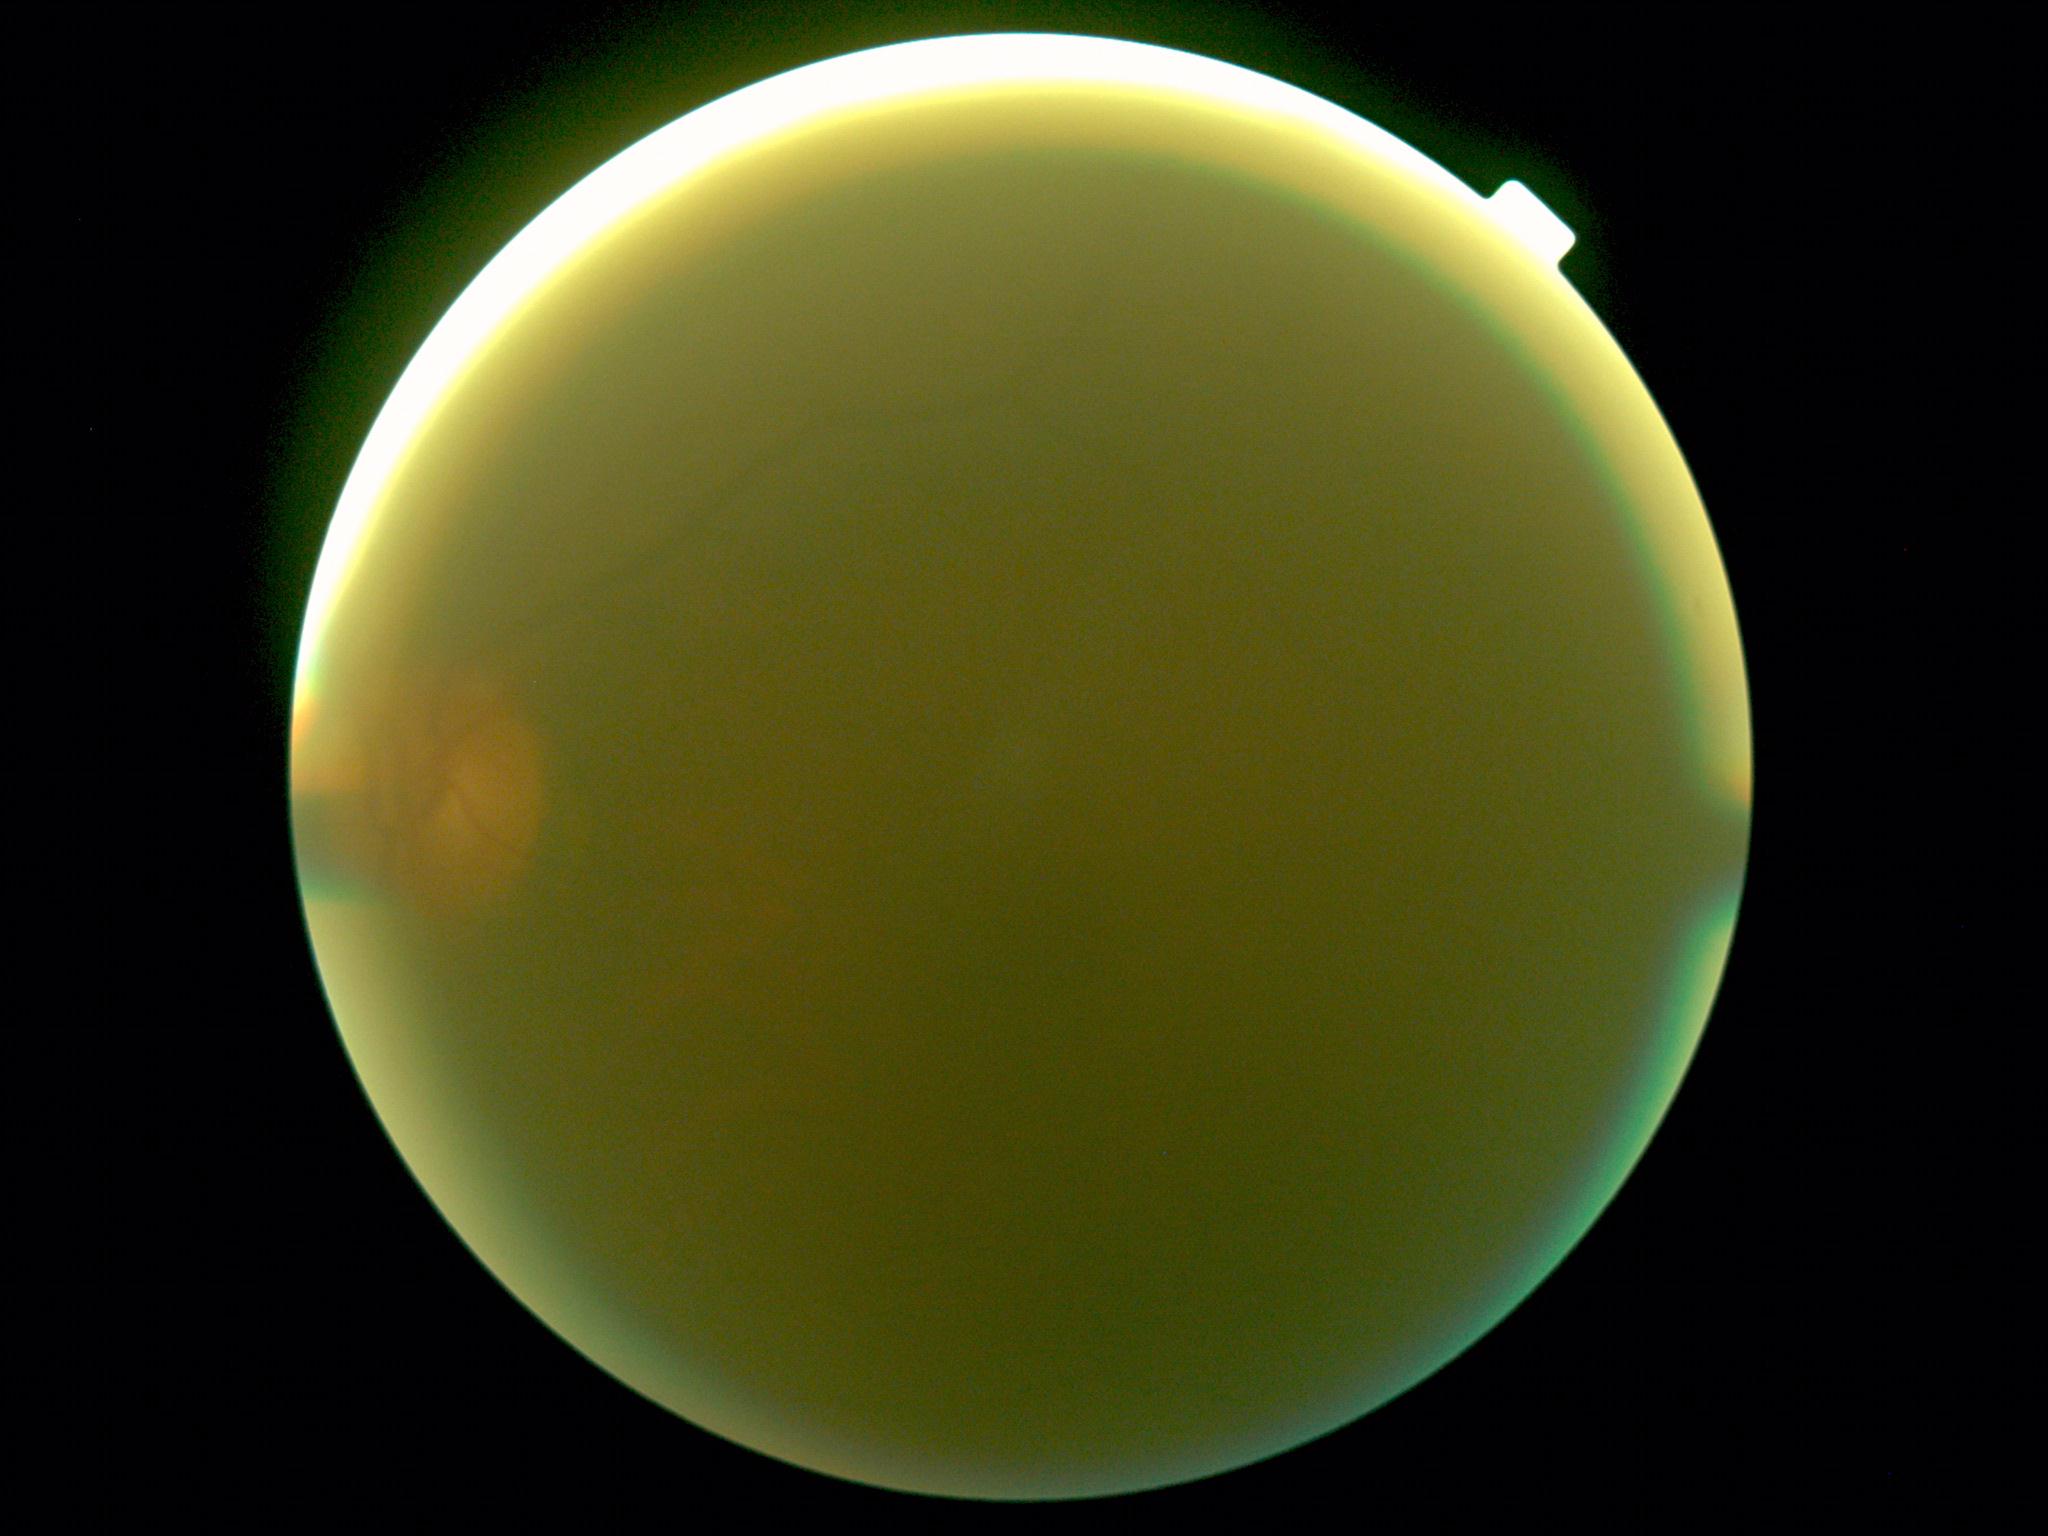

image quality = insufficient for DR assessment
DR = ungradable